Acquired on the Clarity RetCam 3 · pediatric retinal photograph (wide-field) — 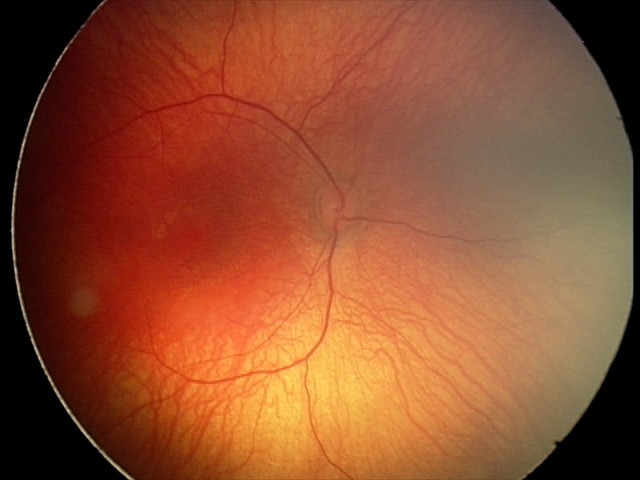
Screening examination with no abnormal retinal findings.